2352x1568.
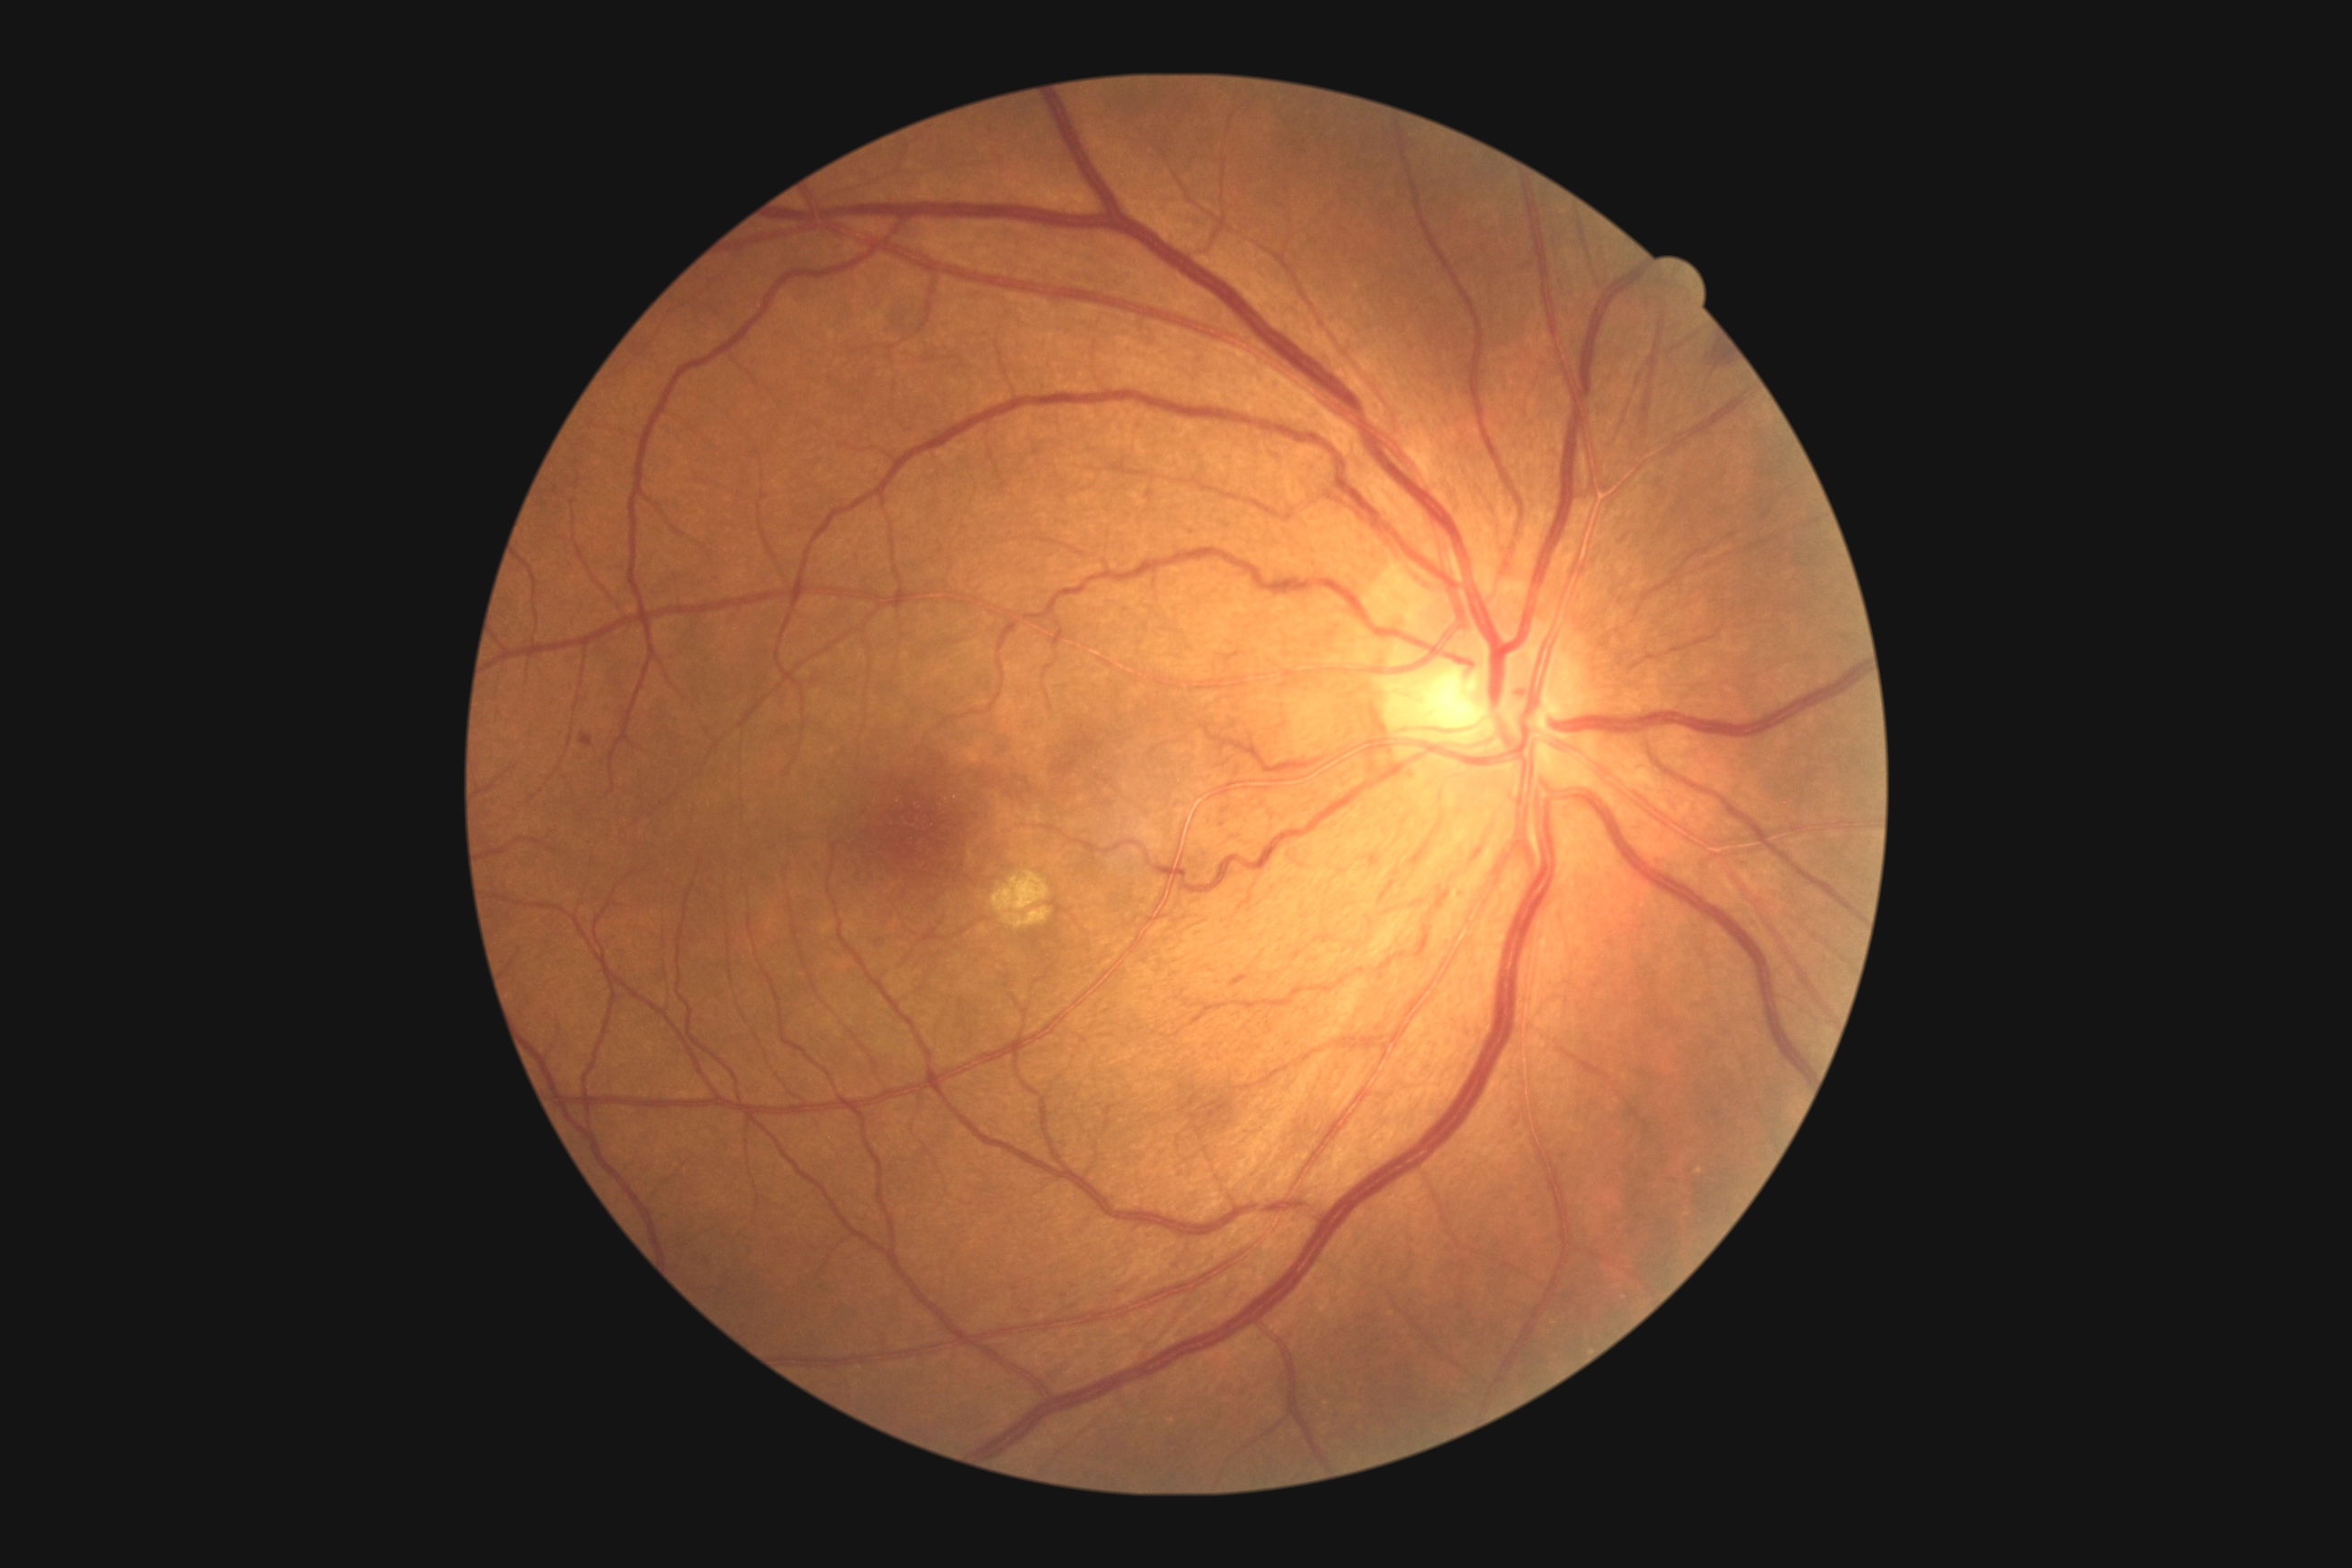 DR=grade 2.